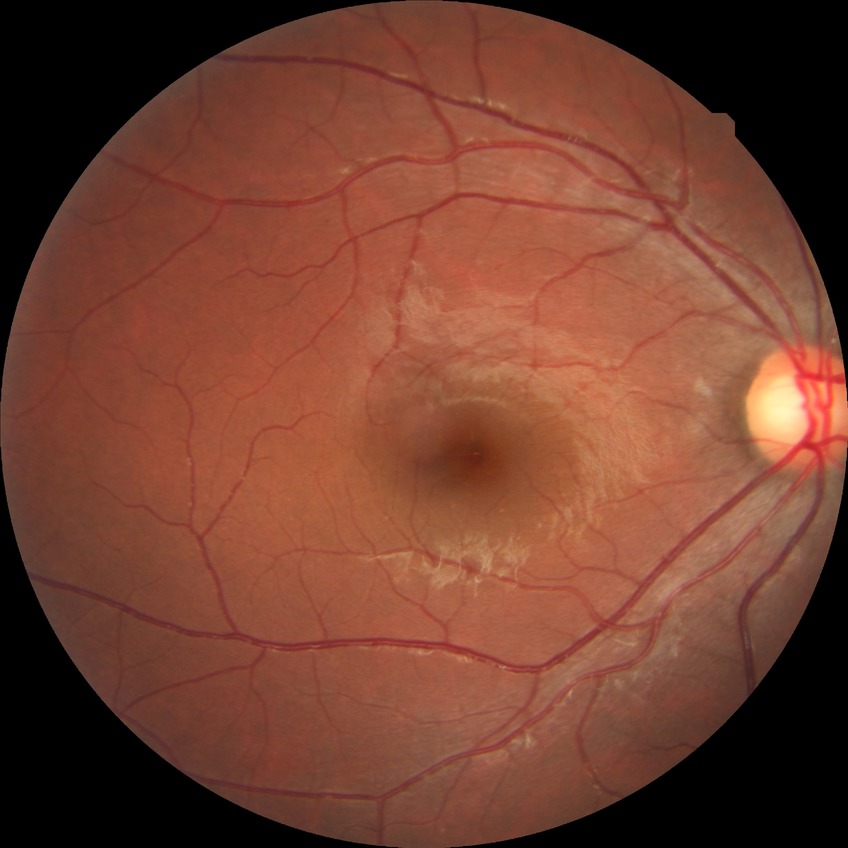

diabetic retinopathy grade=no diabetic retinopathy.